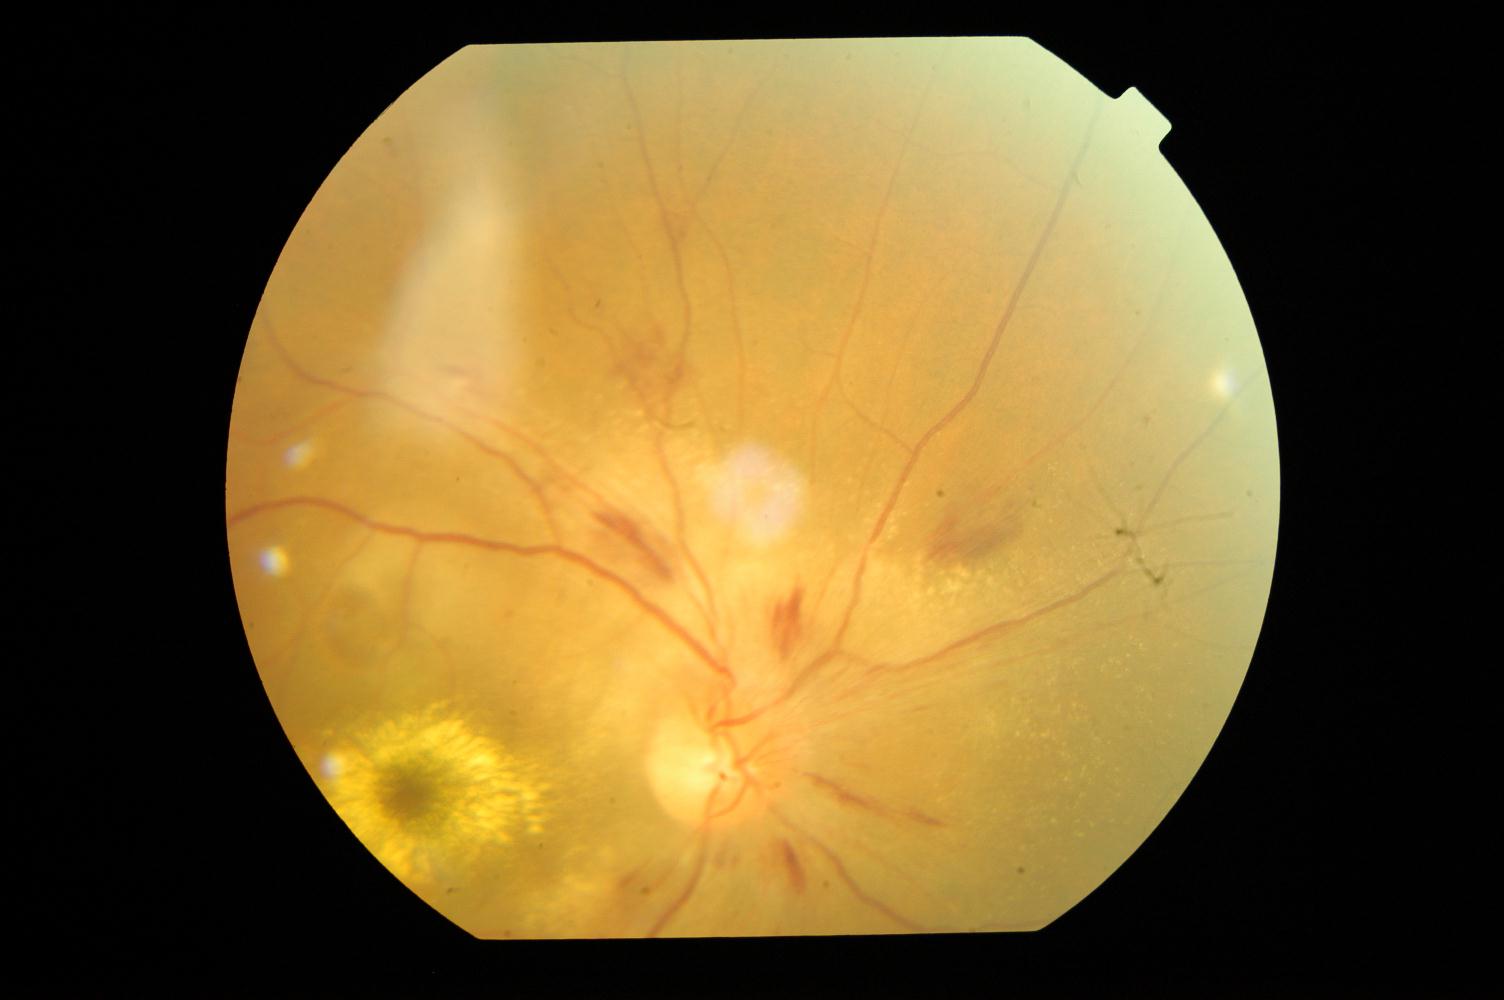 Color fundus photograph showing HTN (hypertensive retinopathy).